CFP, NIDEK AFC-230 fundus camera, 45-degree field of view, no pharmacologic dilation: 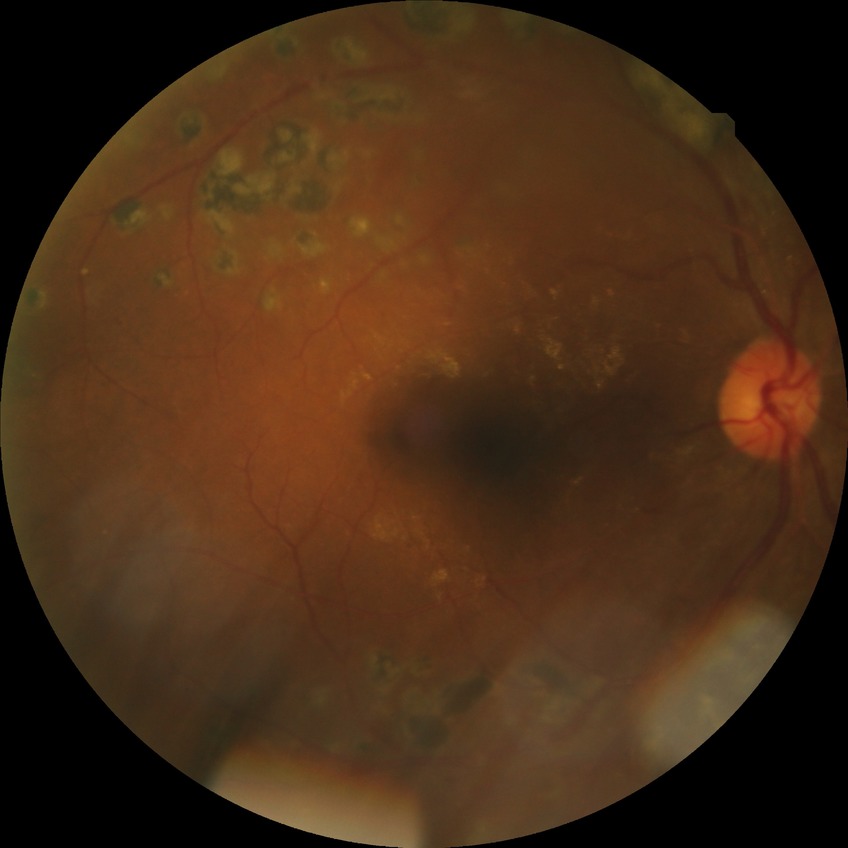 – diabetic retinopathy grade: proliferative diabetic retinopathy